848 by 848 pixels, acquired with a NIDEK AFC-230, FOV: 45 degrees, color fundus image.
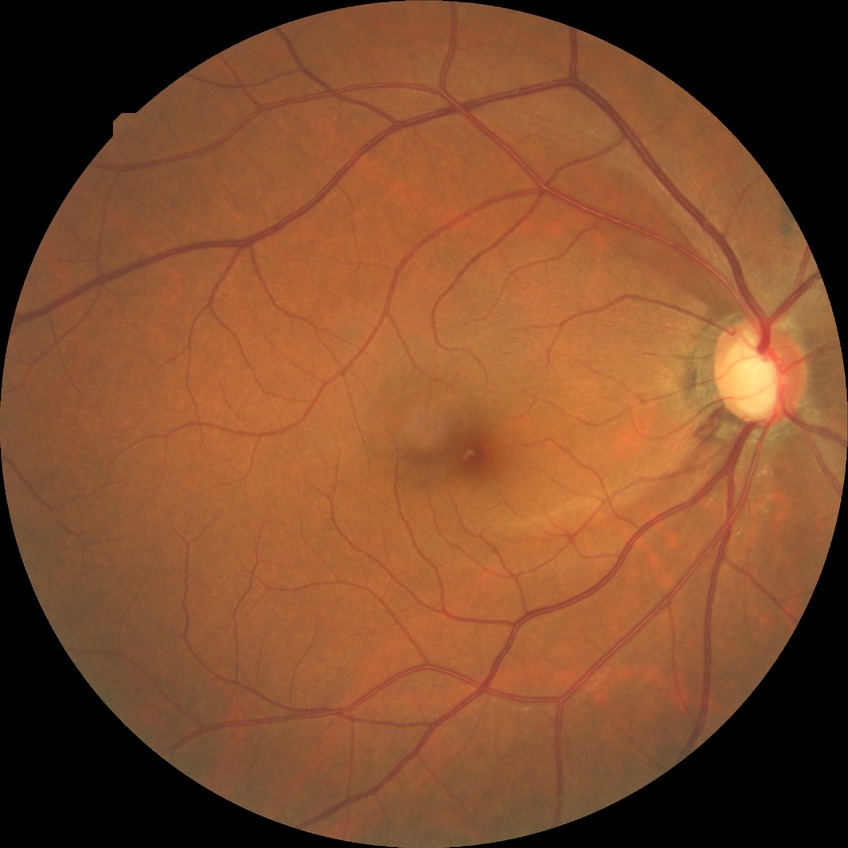

Diabetic retinopathy (DR) is NDR (no diabetic retinopathy).